Fundus photo, 1659x2212, Remidio Fundus on Phone — 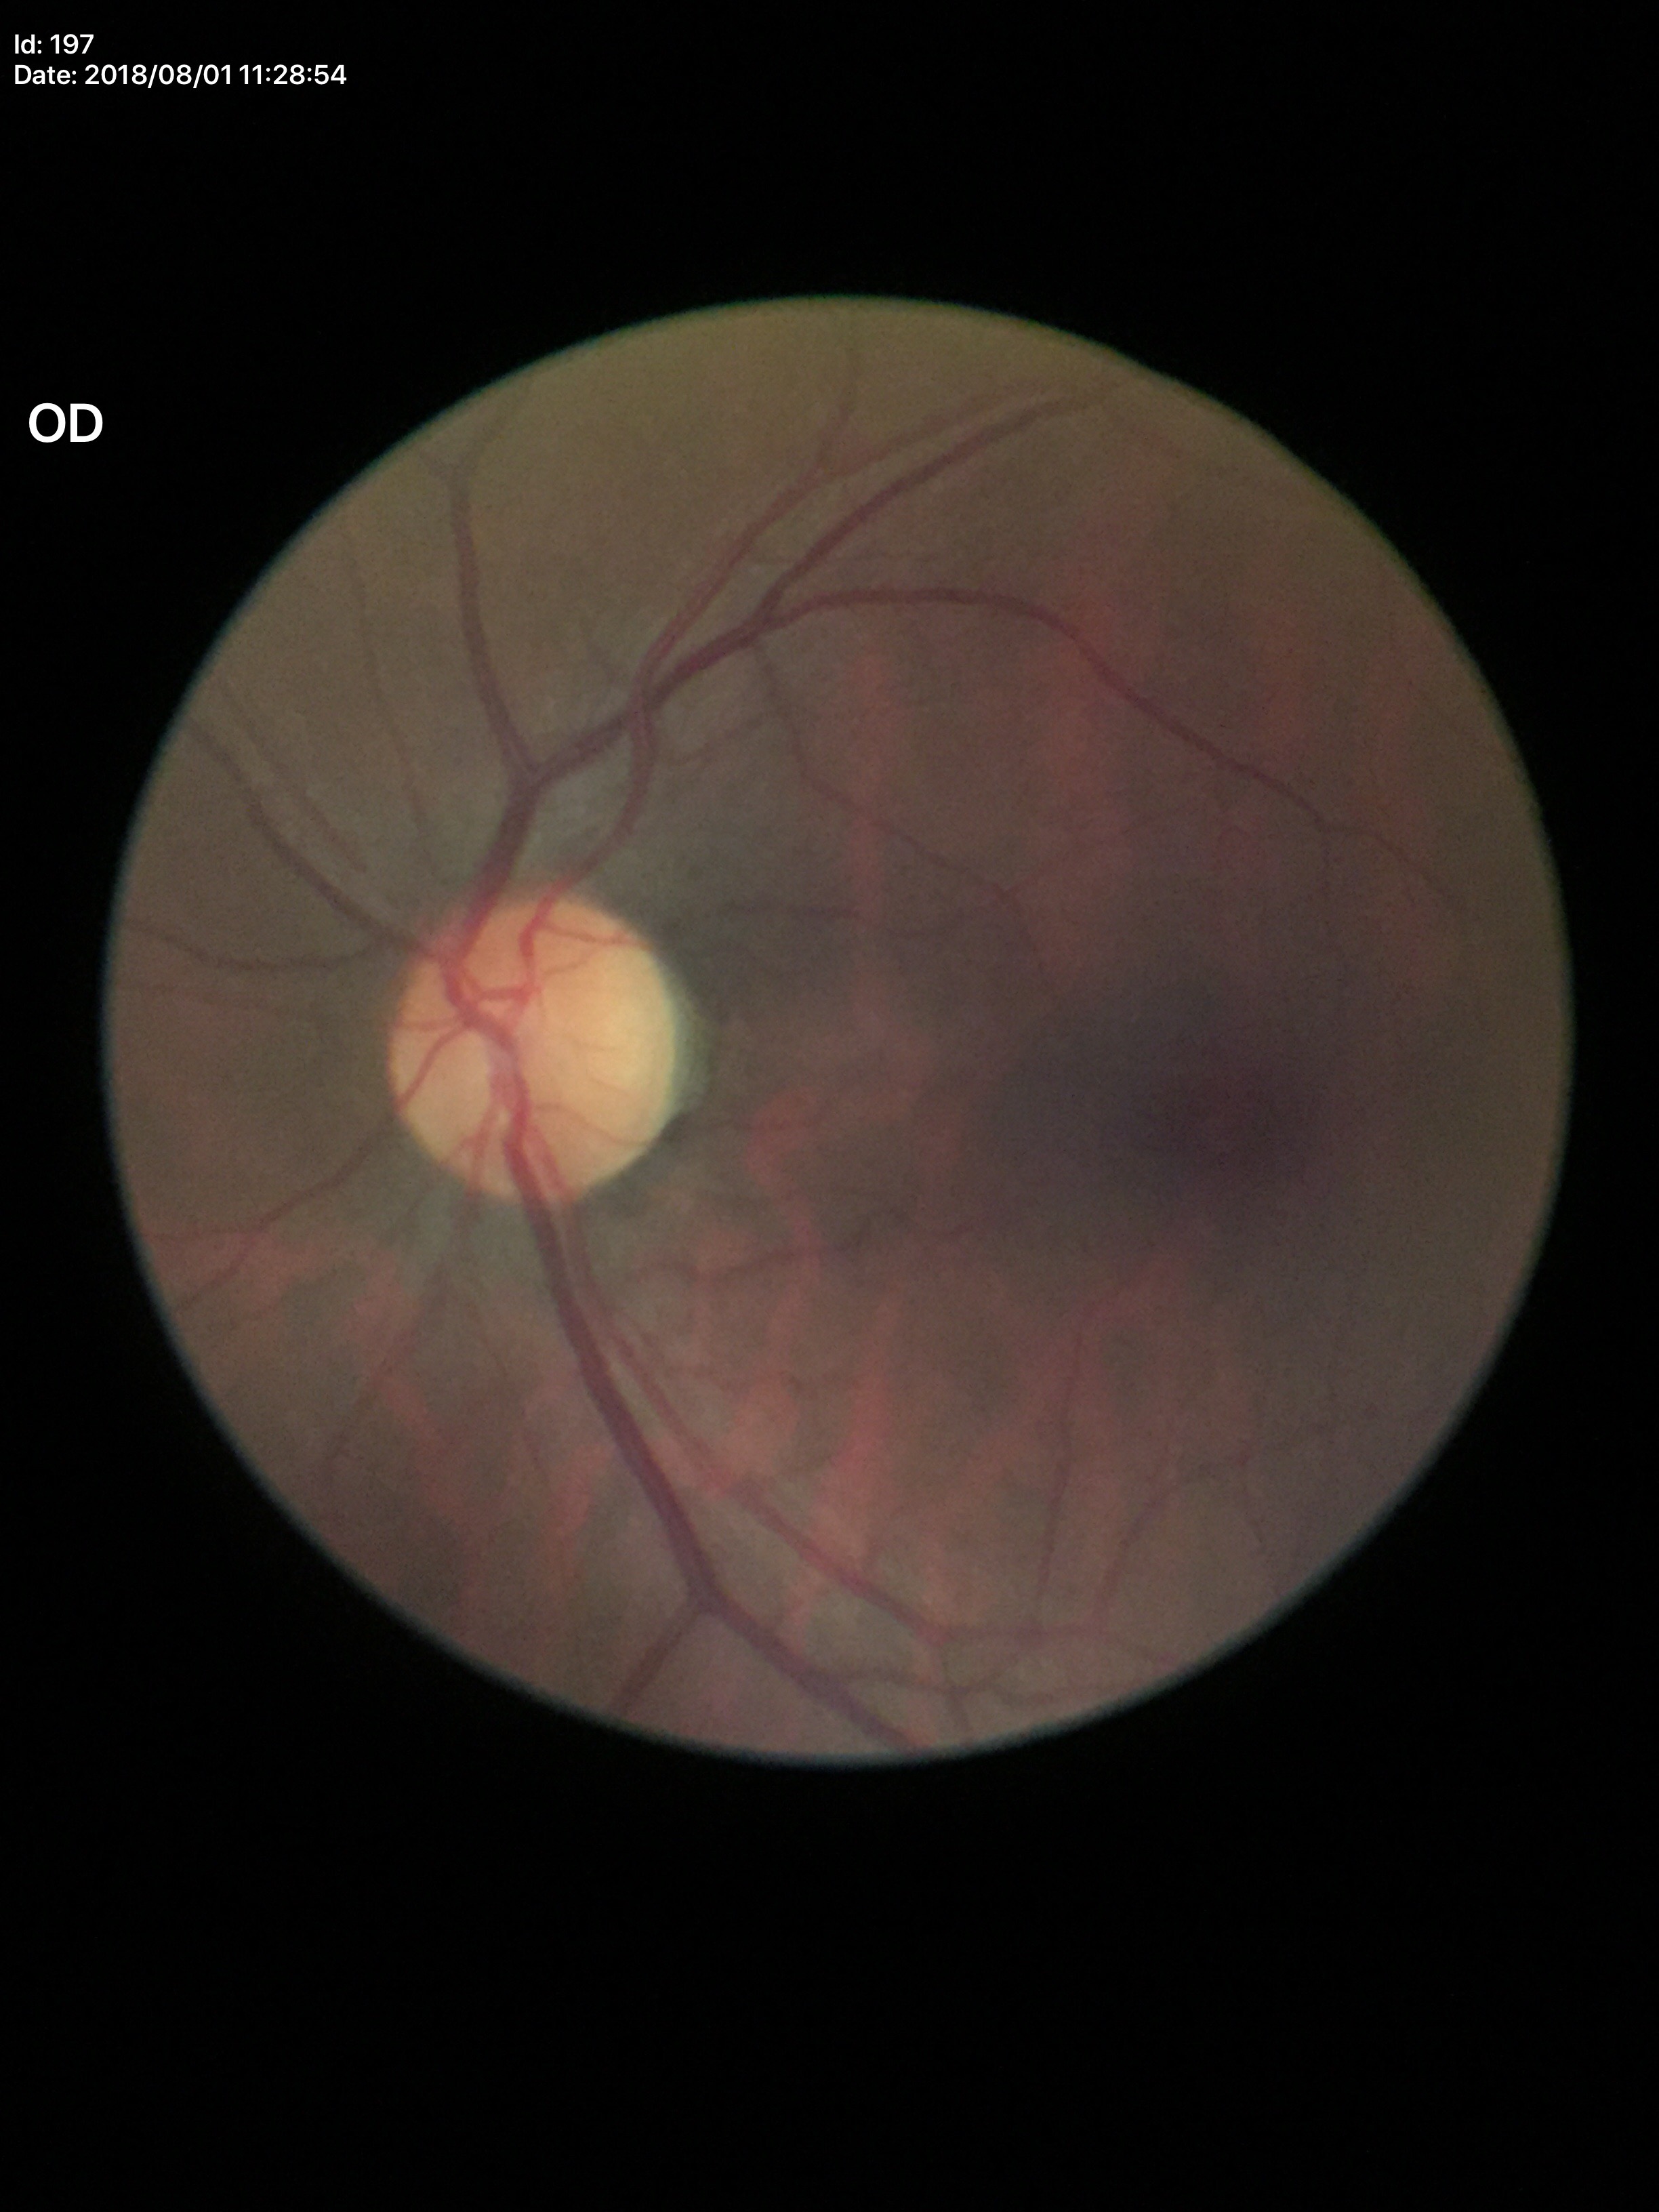 Vertical C/D ratio (VCDR) of 0.44. No evidence of glaucoma.